Nonmydriatic · NIDEK AFC-230 fundus camera: 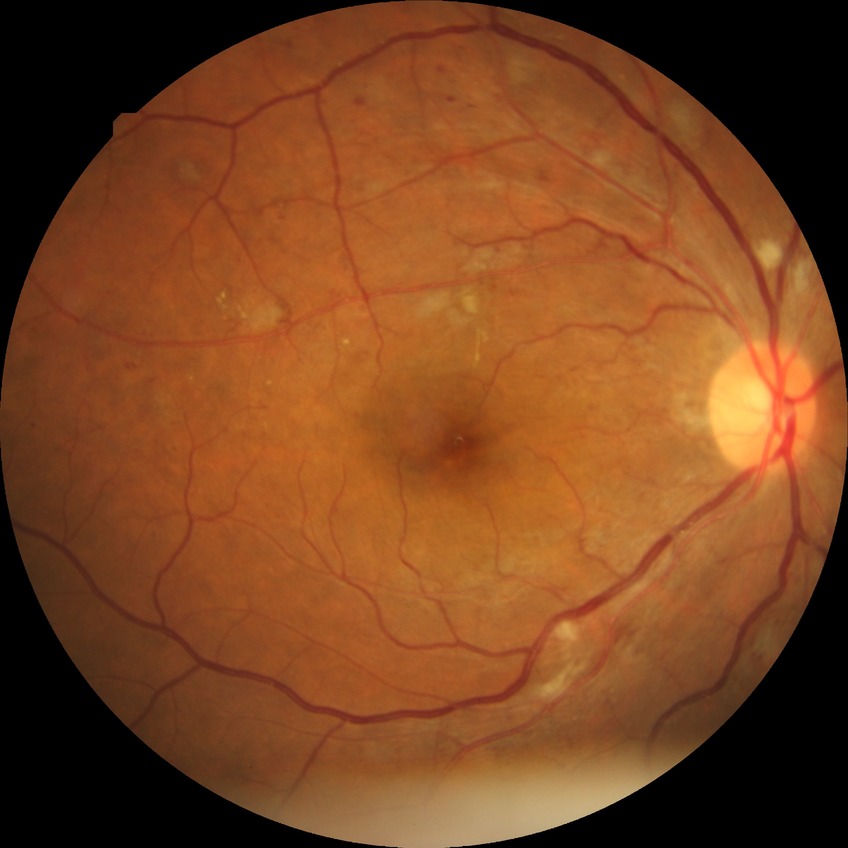

Diabetic retinopathy (DR) is pre-proliferative diabetic retinopathy (PPDR).